45° field of view, acquired with a NIDEK AFC-230 — 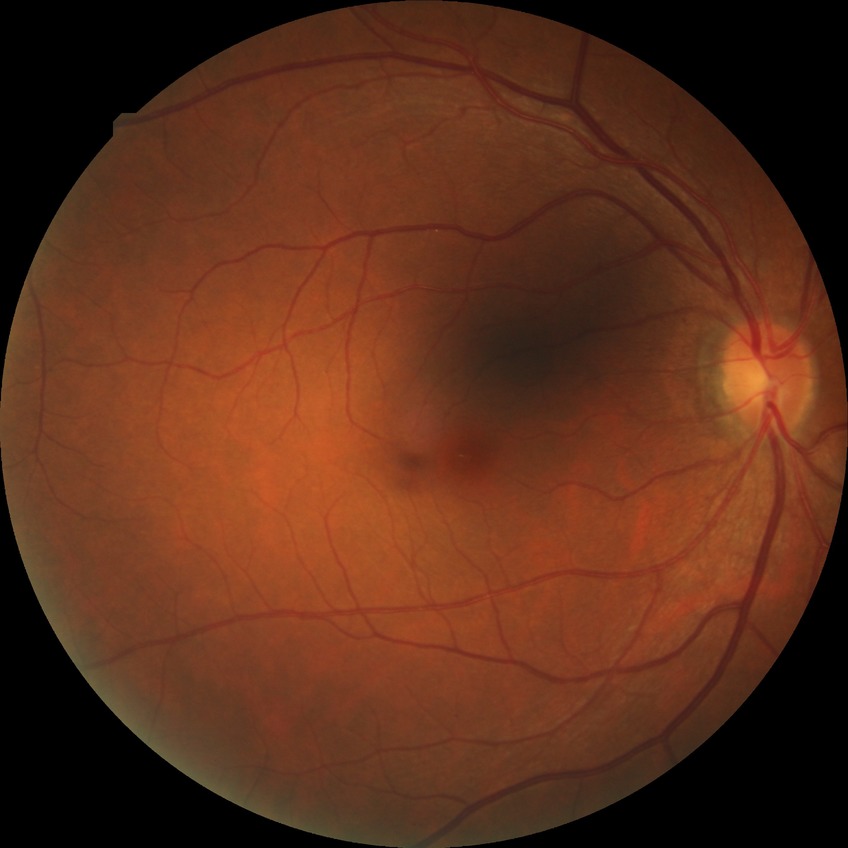 Davis DR grade=NDR; DR impression=no DR findings.